Wide-field fundus image from infant ROP screening · 1240x1240px · acquired on the Phoenix ICON
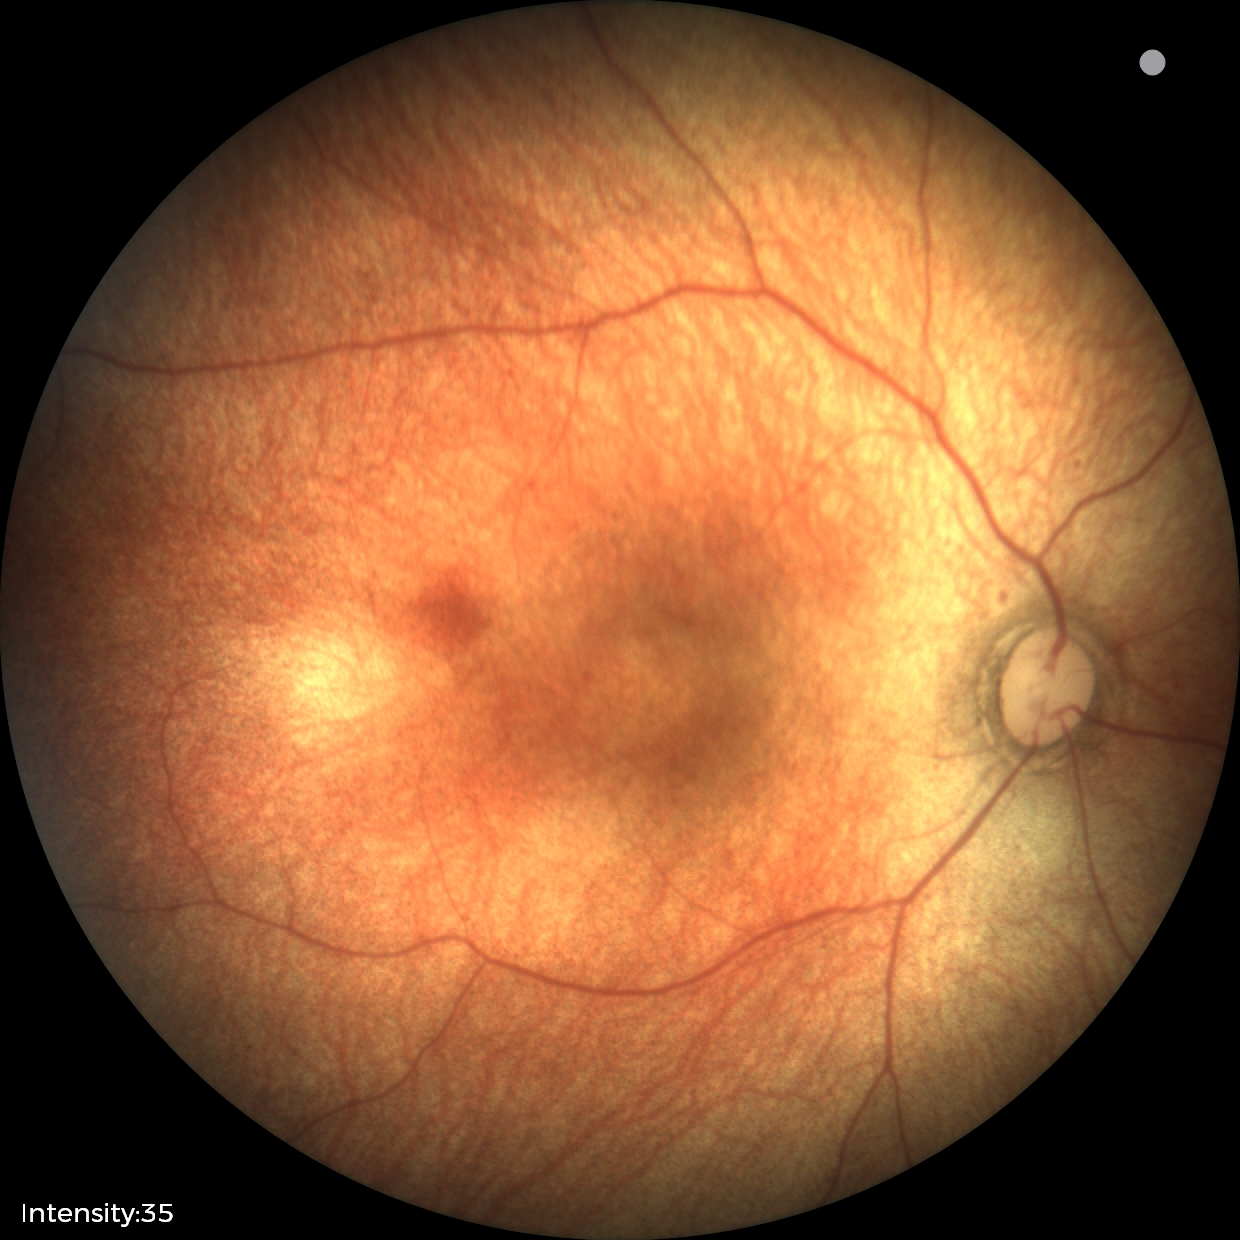 Diagnosis: no abnormalities